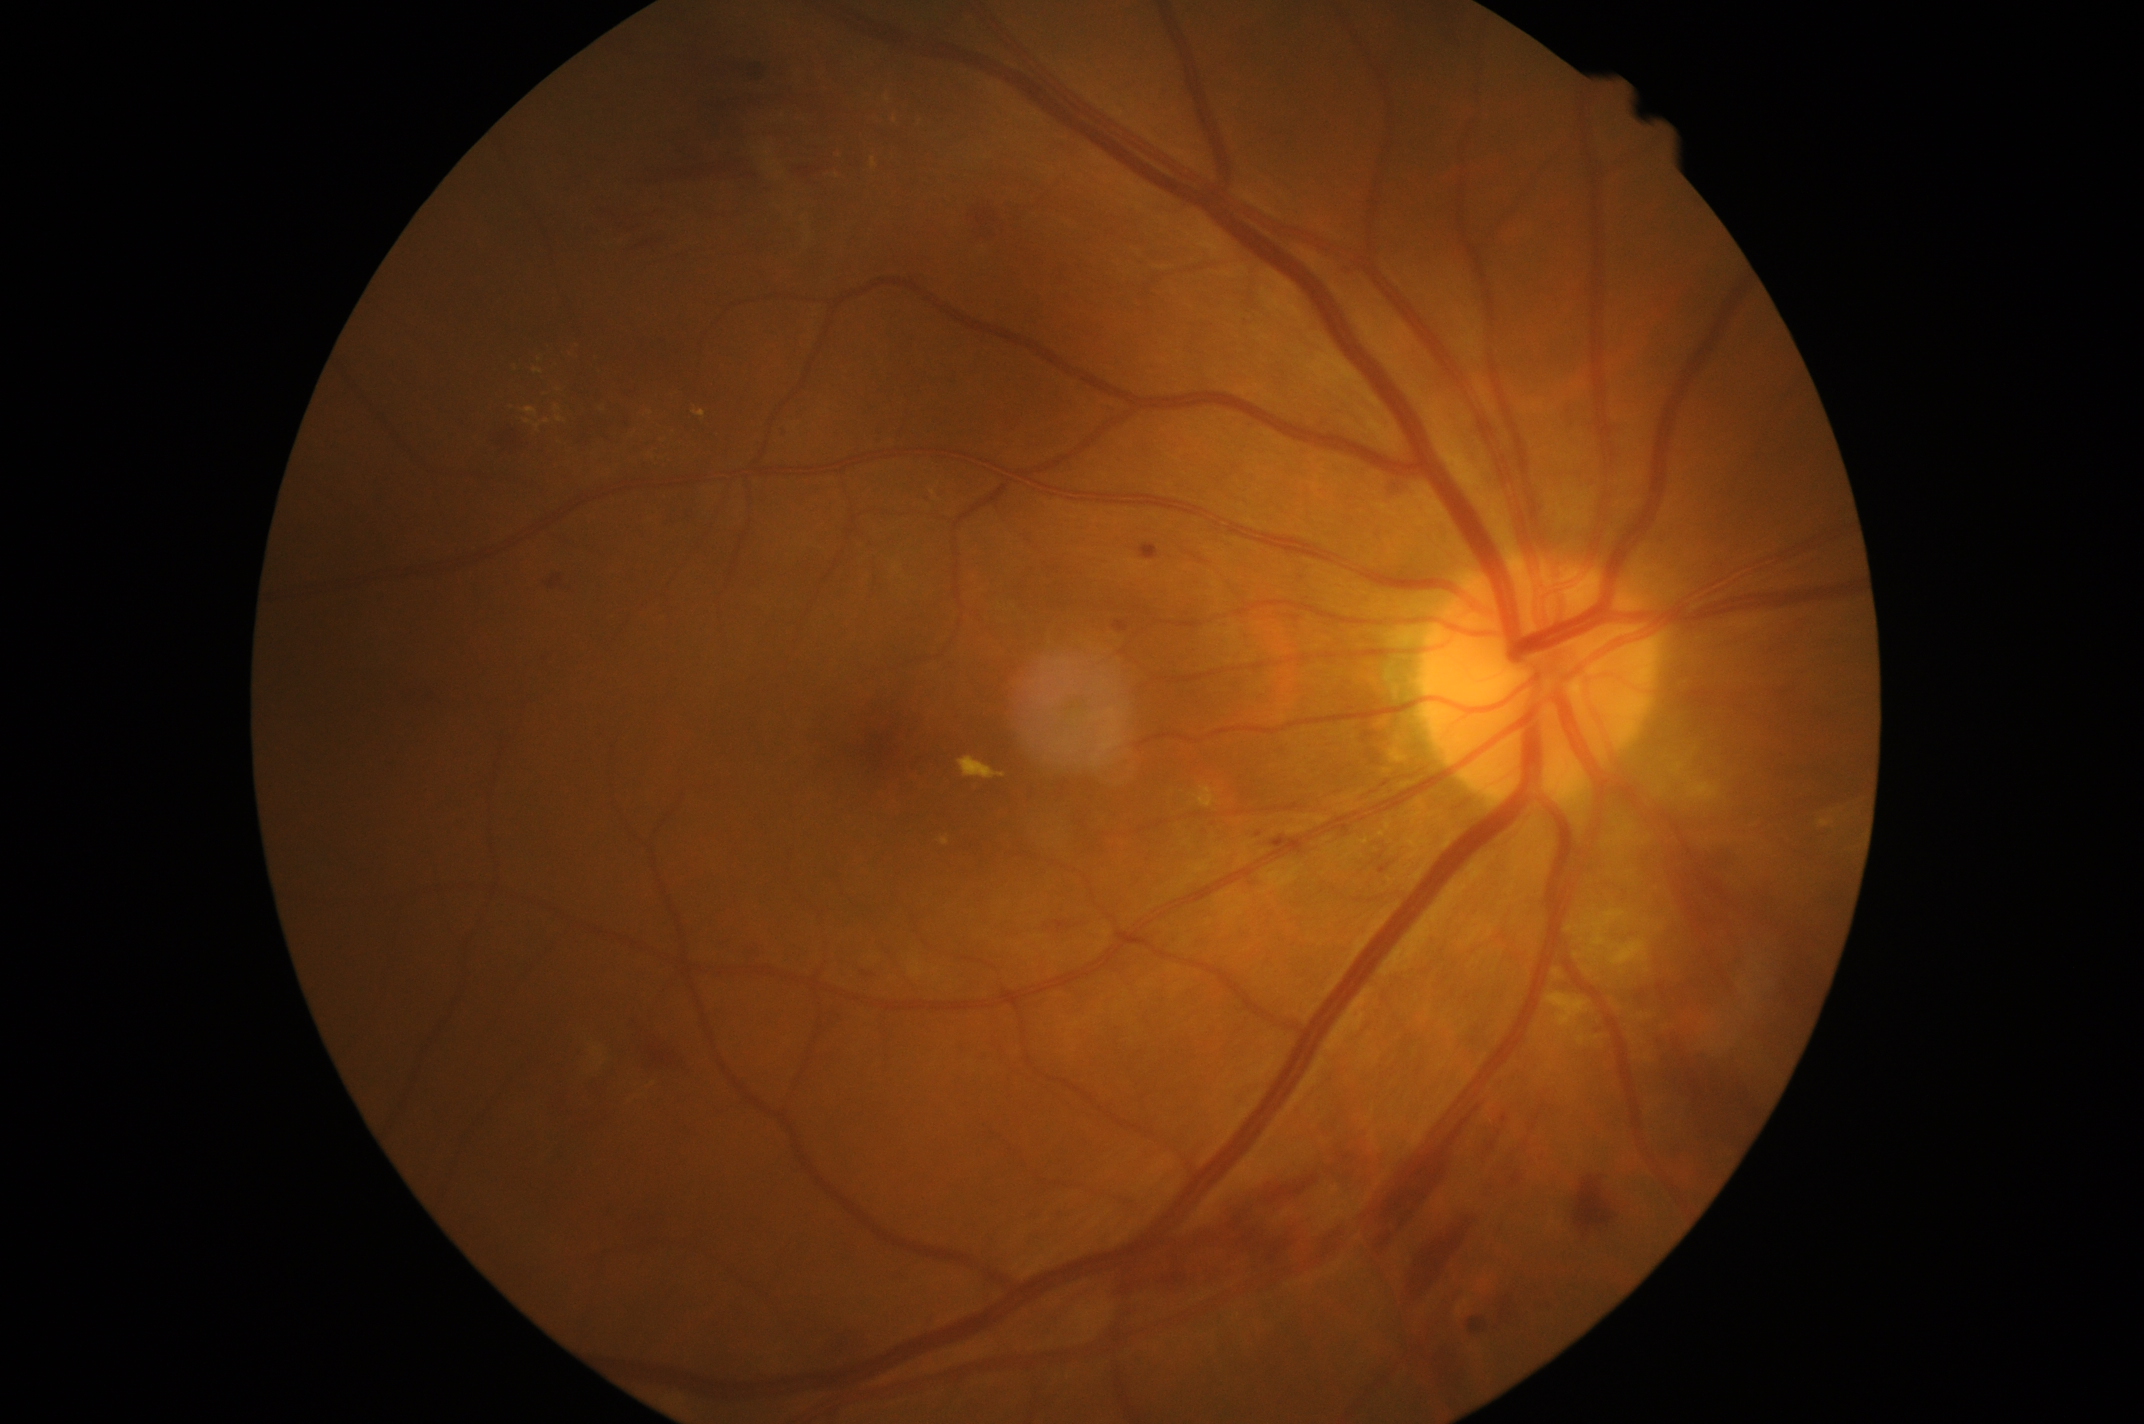

Annotations:
- diabetic retinopathy severity — moderate non-proliferative diabetic retinopathy (grade 2) — more than just microaneurysms but less than severe NPDR